Camera: Forus 3Nethra fundus camera.
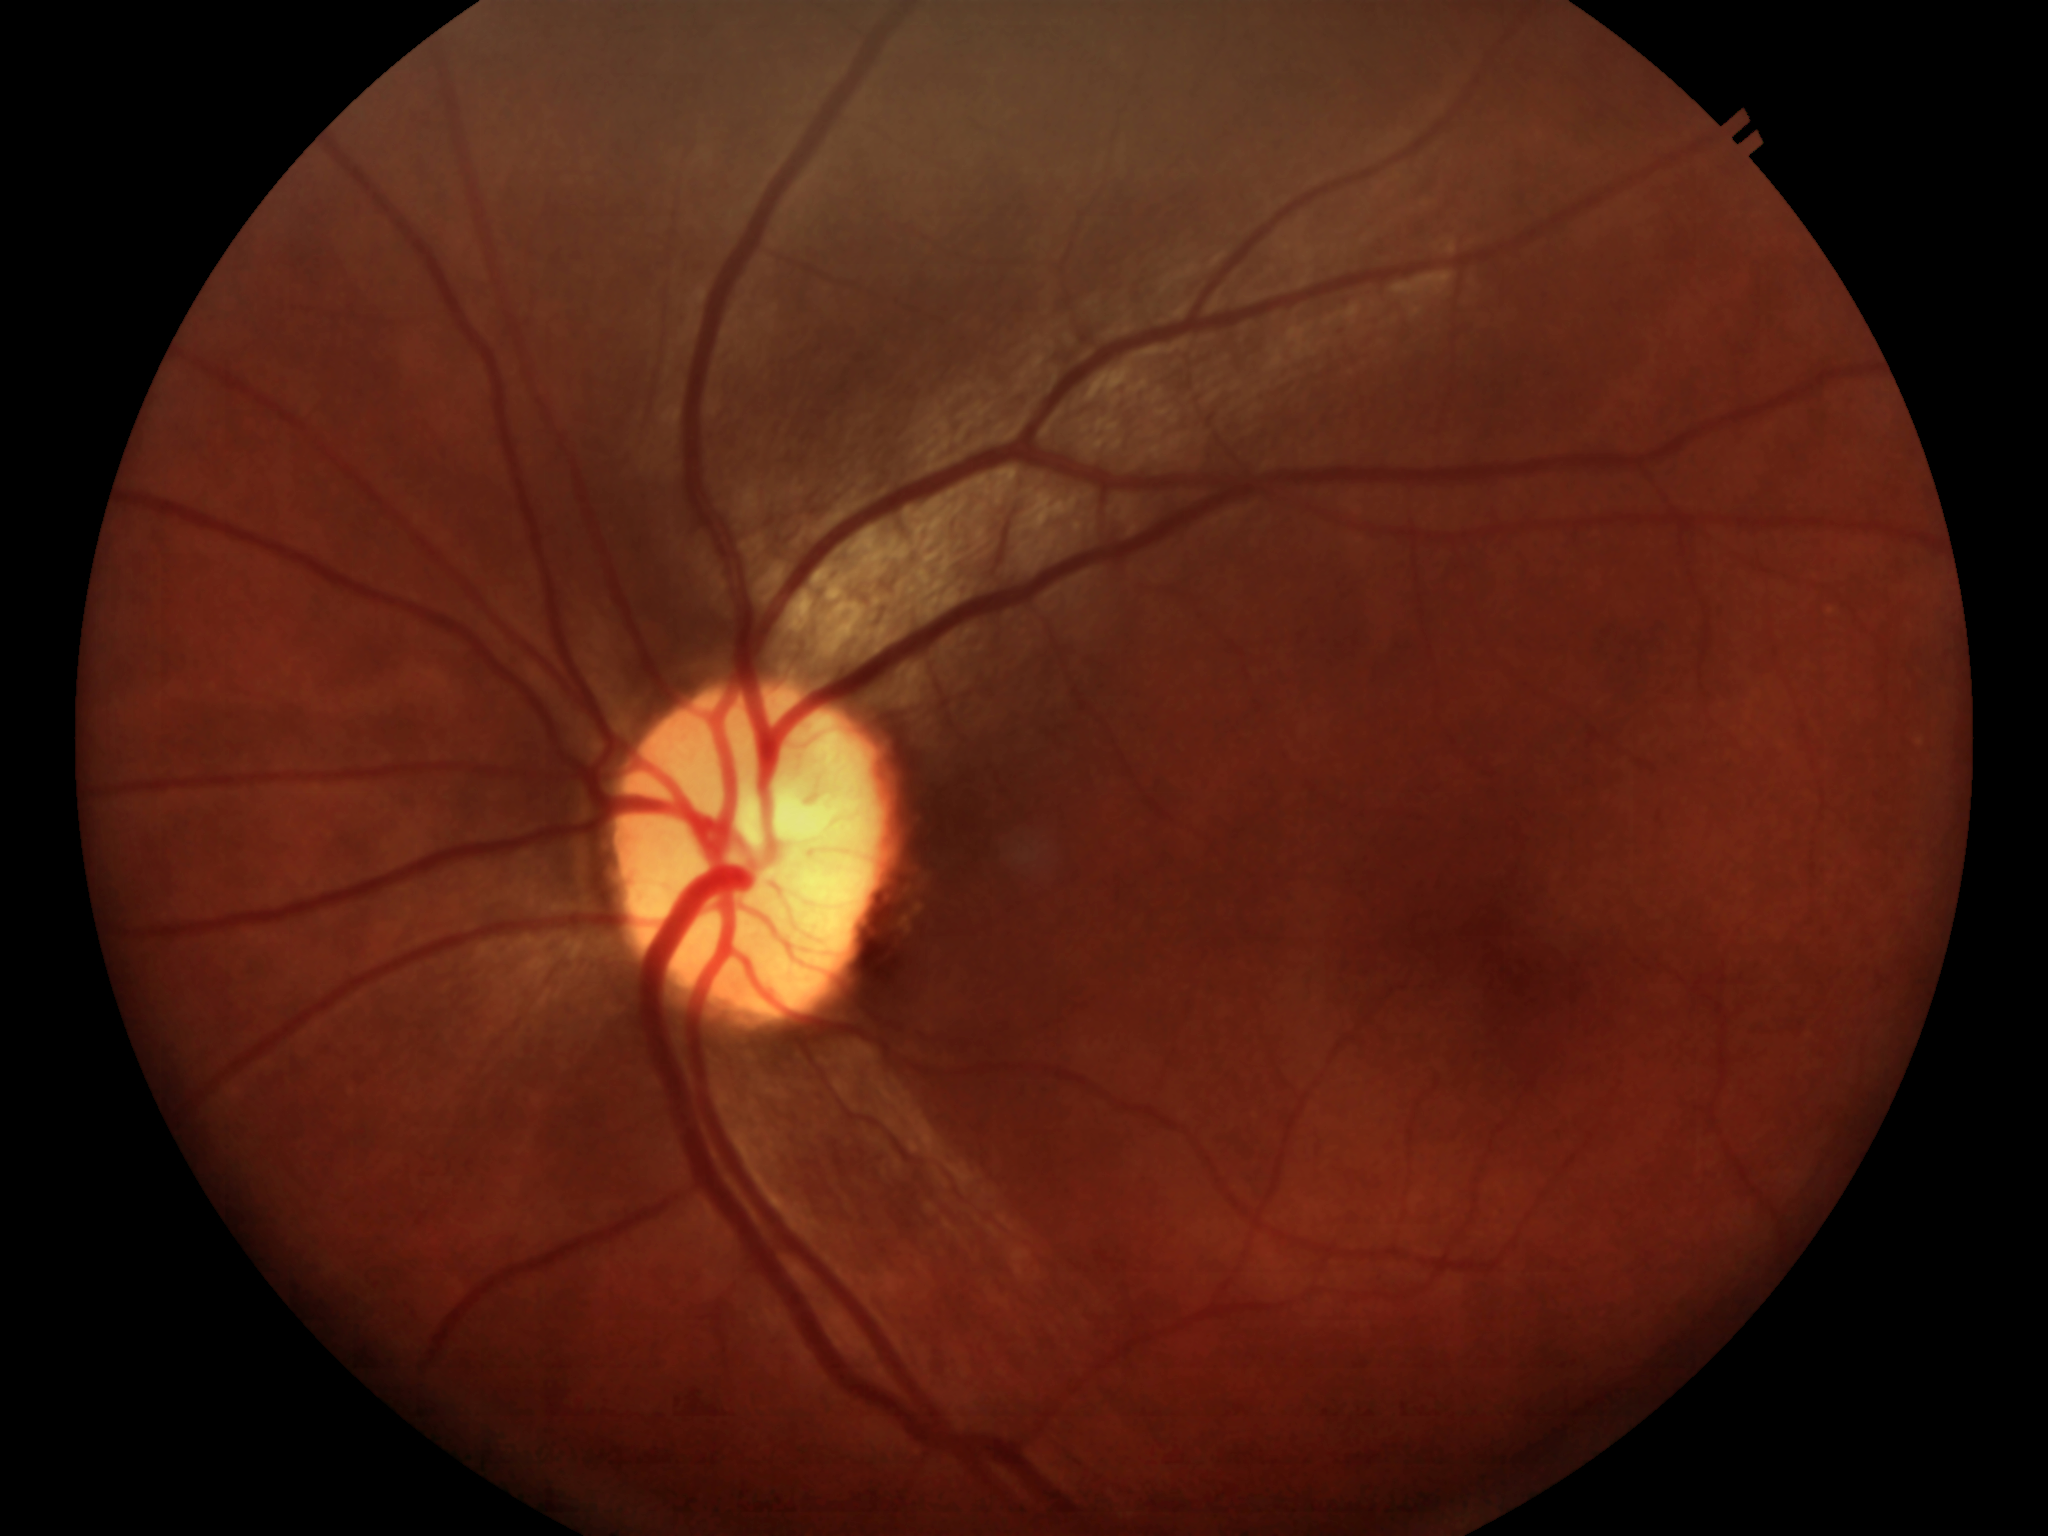 Glaucoma decision: negative. Horizontal CDR of 0.45. Vertical cup-disc ratio: 0.48.